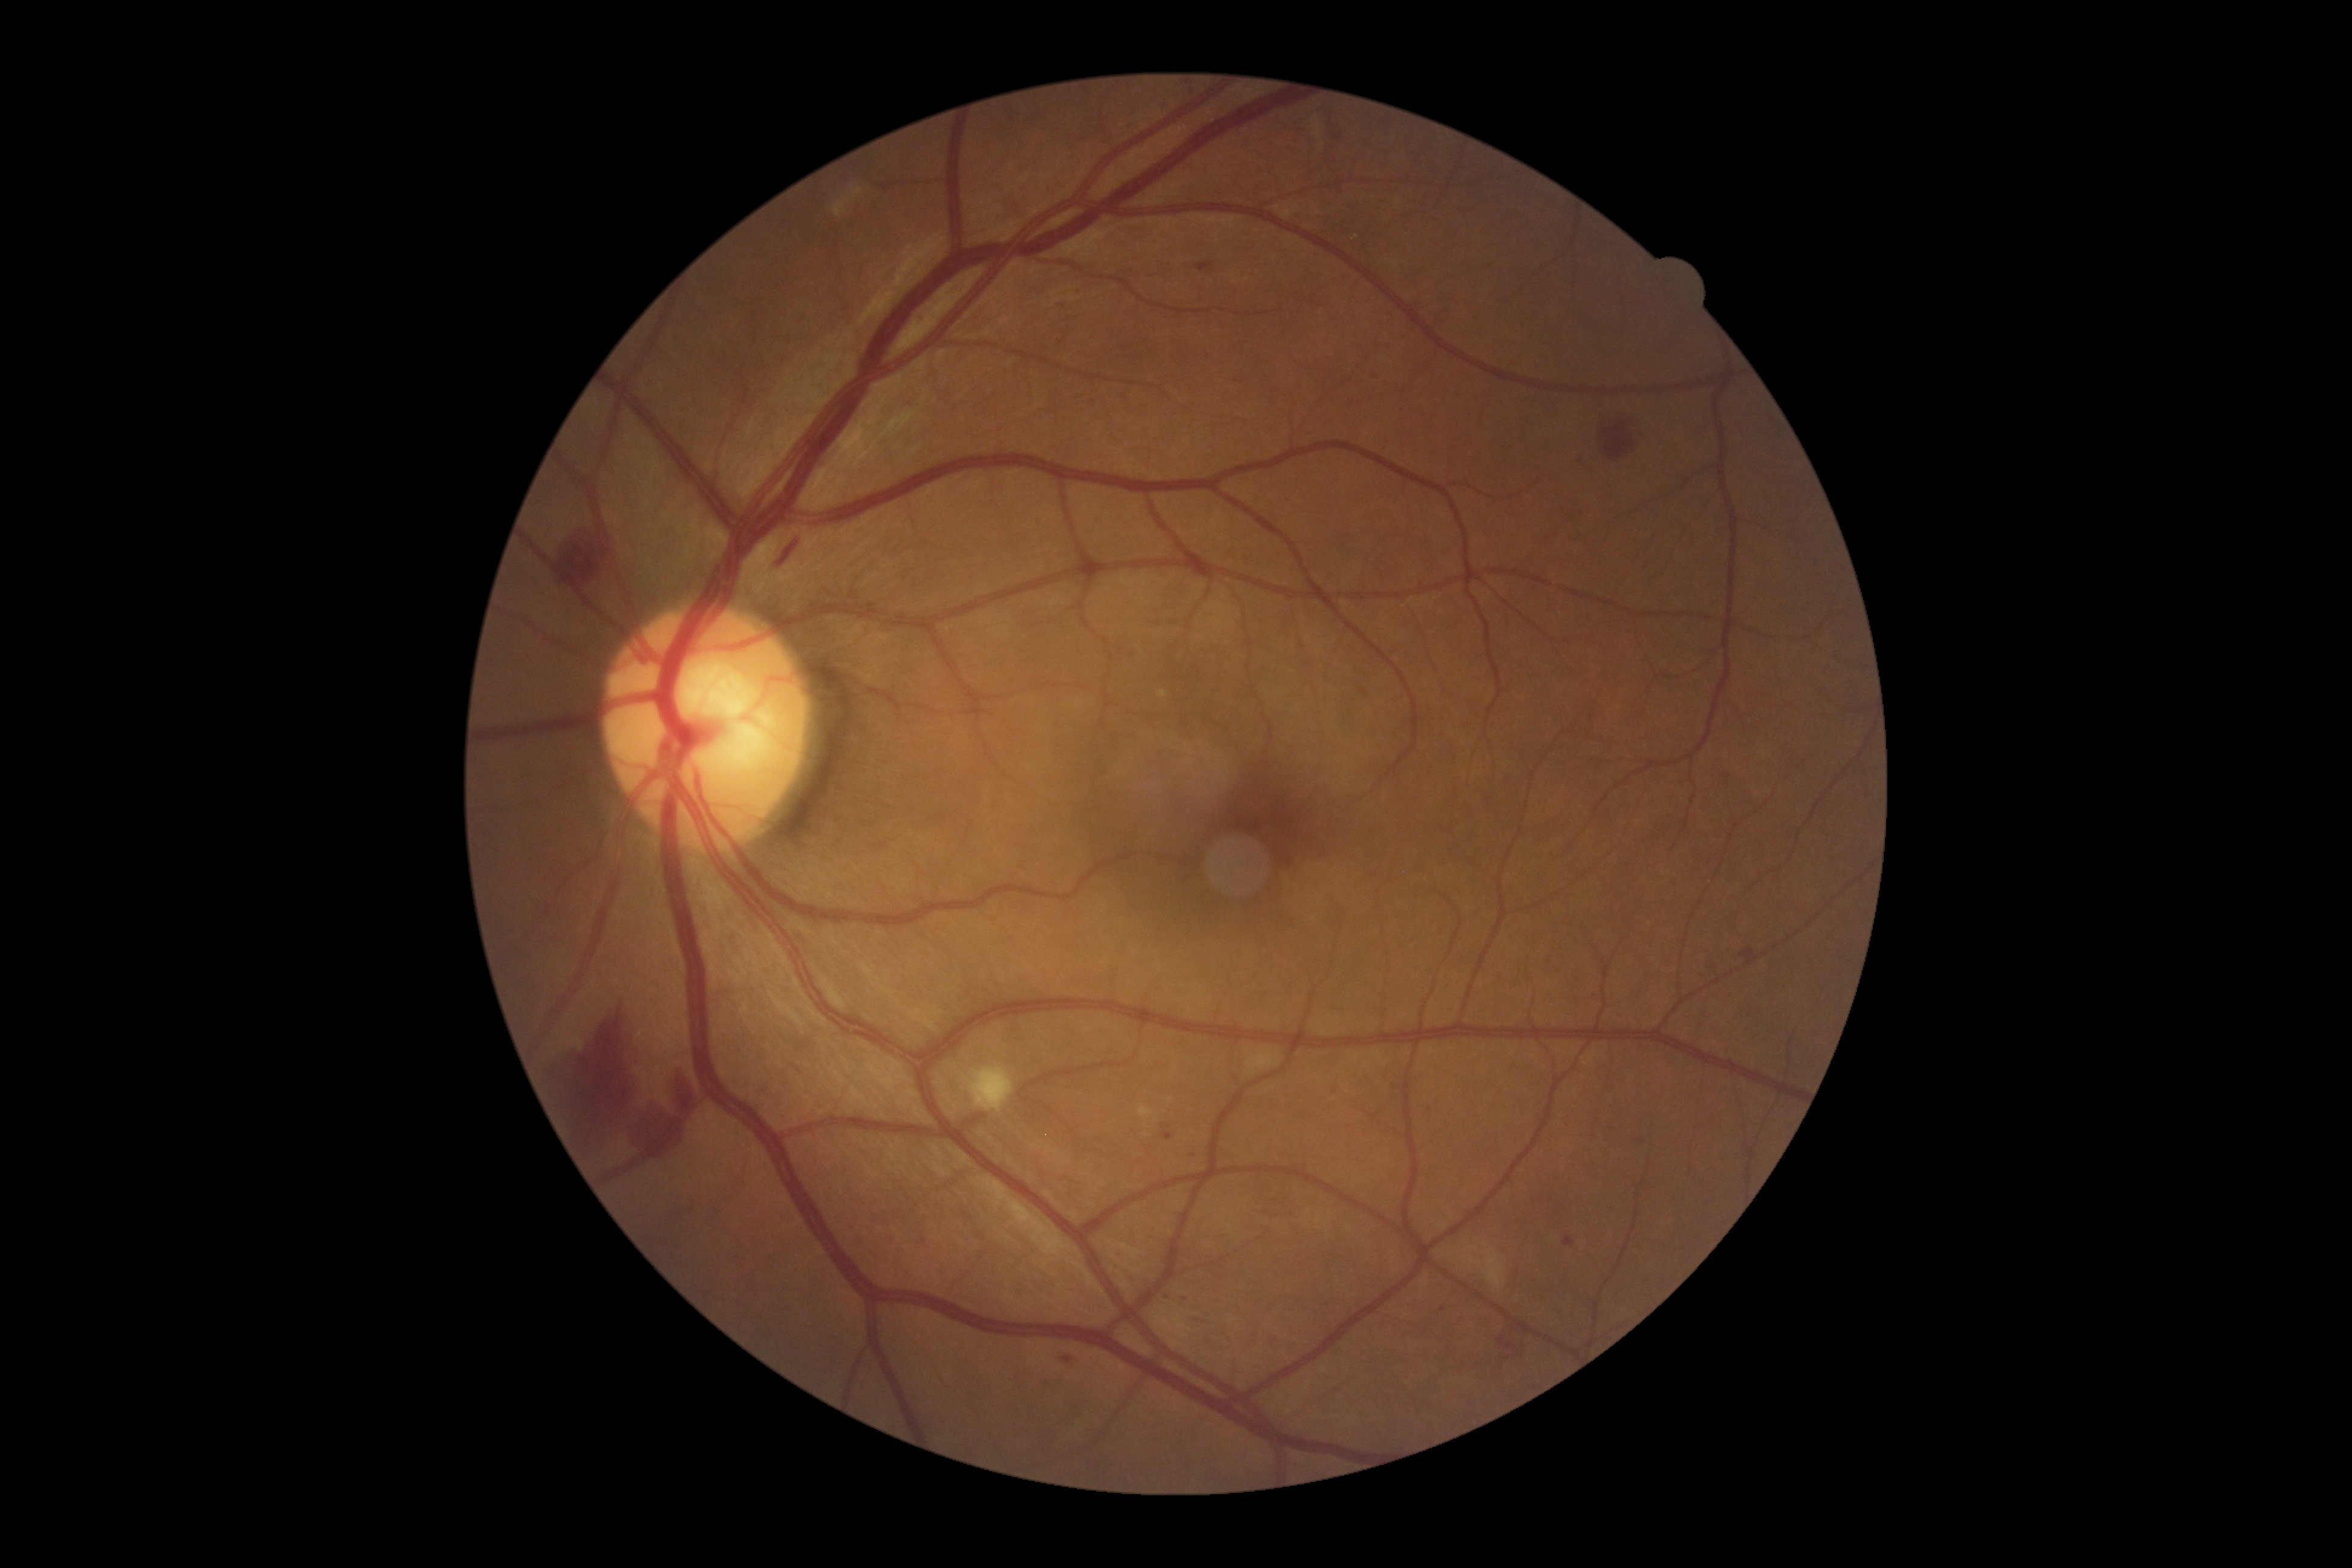
Diabetic retinopathy (DR): 2
A subset of detected lesions:
soft exudates (SEs): [961, 1060, 1013, 1112], [1449, 1244, 1508, 1290]
hard exudates (EXs): none detected
microaneurysms (MAs) (more not shown): [1162, 1131, 1174, 1140], [1204, 347, 1212, 356], [1638, 1140, 1646, 1144], [1161, 1123, 1171, 1128], [1068, 1356, 1079, 1367], [1500, 1334, 1507, 1342], [1195, 261, 1214, 274], [1564, 1233, 1575, 1246], [1187, 1148, 1197, 1166], [1180, 1290, 1187, 1299], [1167, 1287, 1174, 1299], [1740, 948, 1759, 965], [1507, 1341, 1515, 1348]
MAs (small, approximate centers) near x=1336 y=138, x=1398 y=1086, x=1060 y=306, x=1430 y=1108, x=1376 y=376, x=1132 y=655
hemorrhages (HEs): [1604, 424, 1636, 460], [770, 537, 803, 574], [632, 1070, 696, 1158], [549, 1005, 639, 1146], [551, 526, 606, 589]